NIDEK AFC-230 fundus camera, without pupil dilation
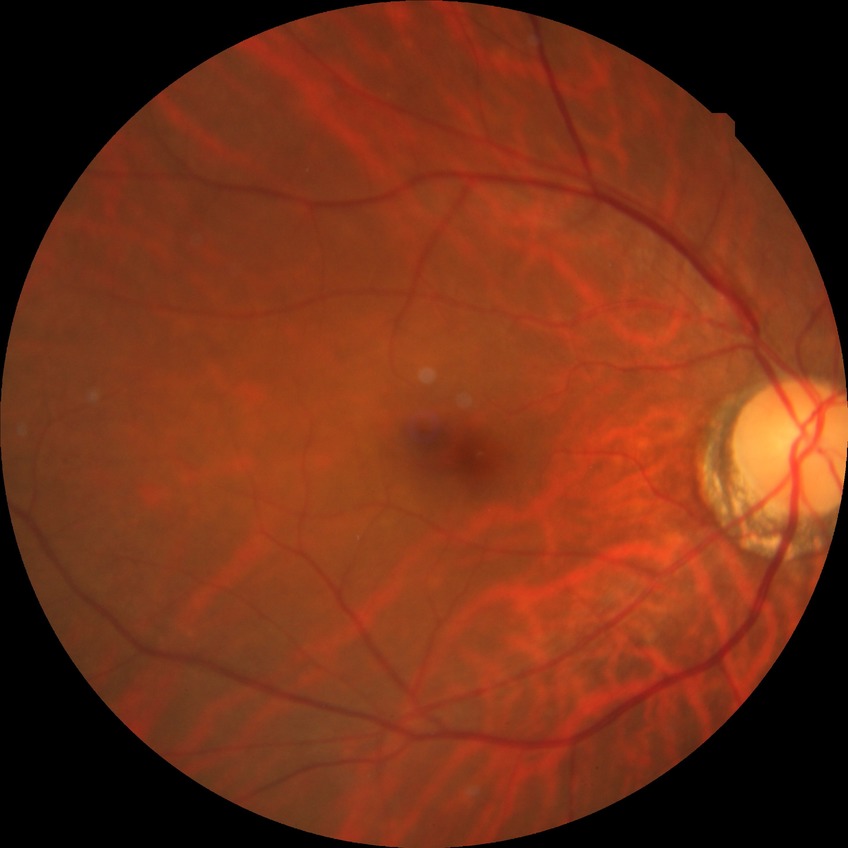
Modified Davis classification is no diabetic retinopathy.